Pediatric retinal photograph (wide-field); 1240 by 1240 pixels — 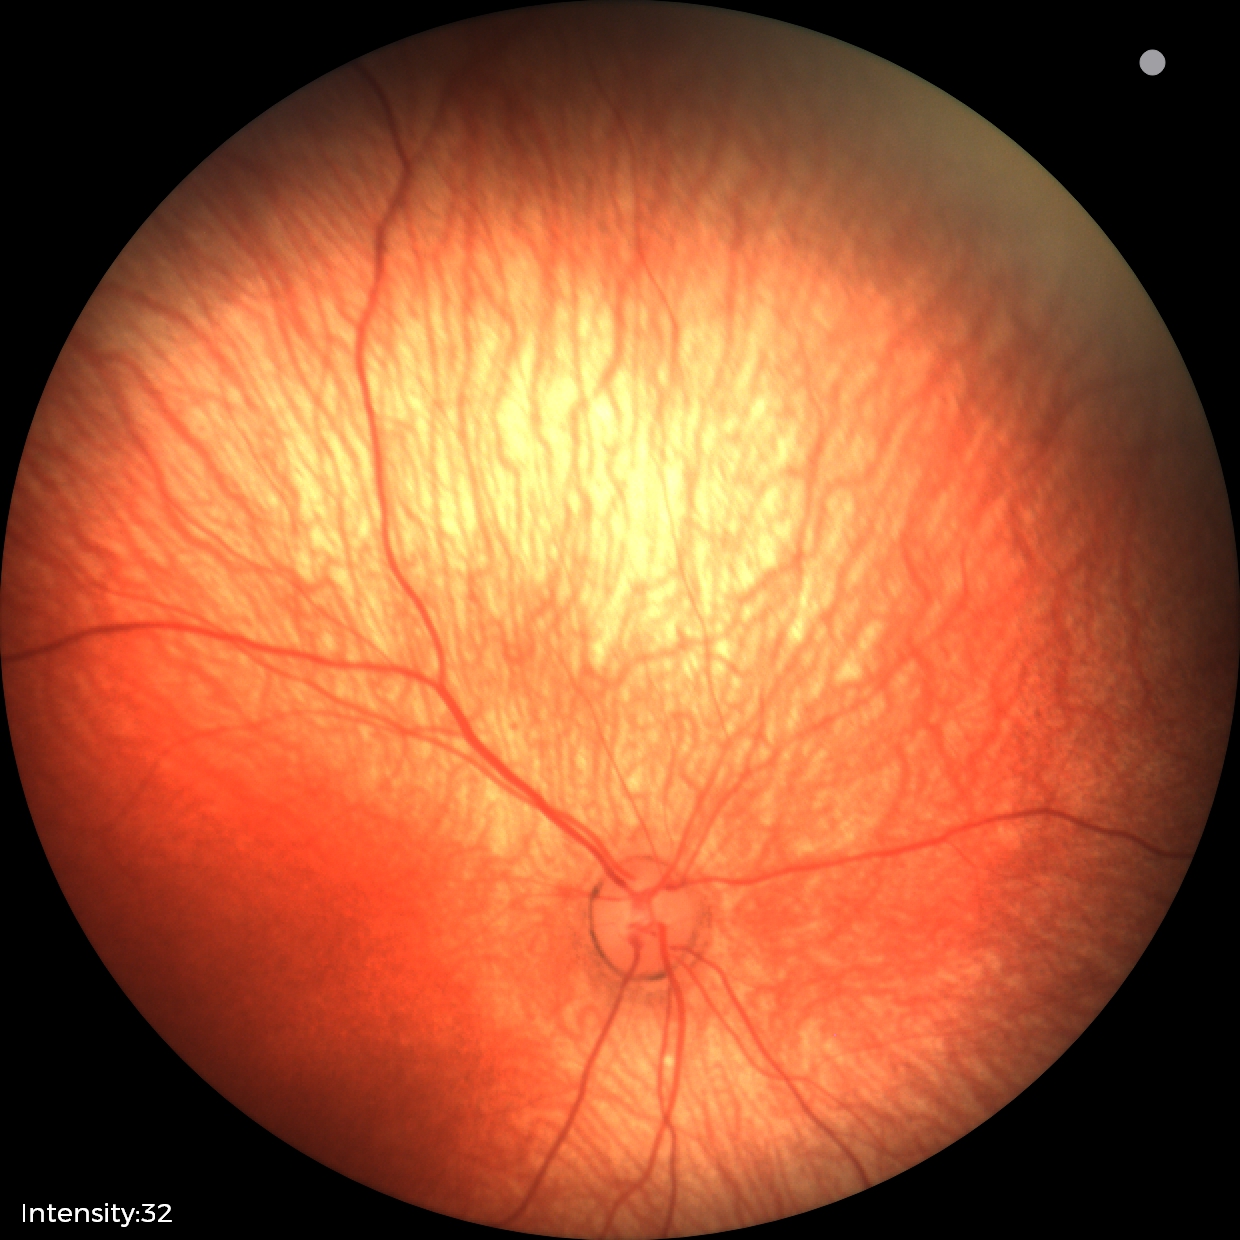 Screening examination diagnosed as physiological.